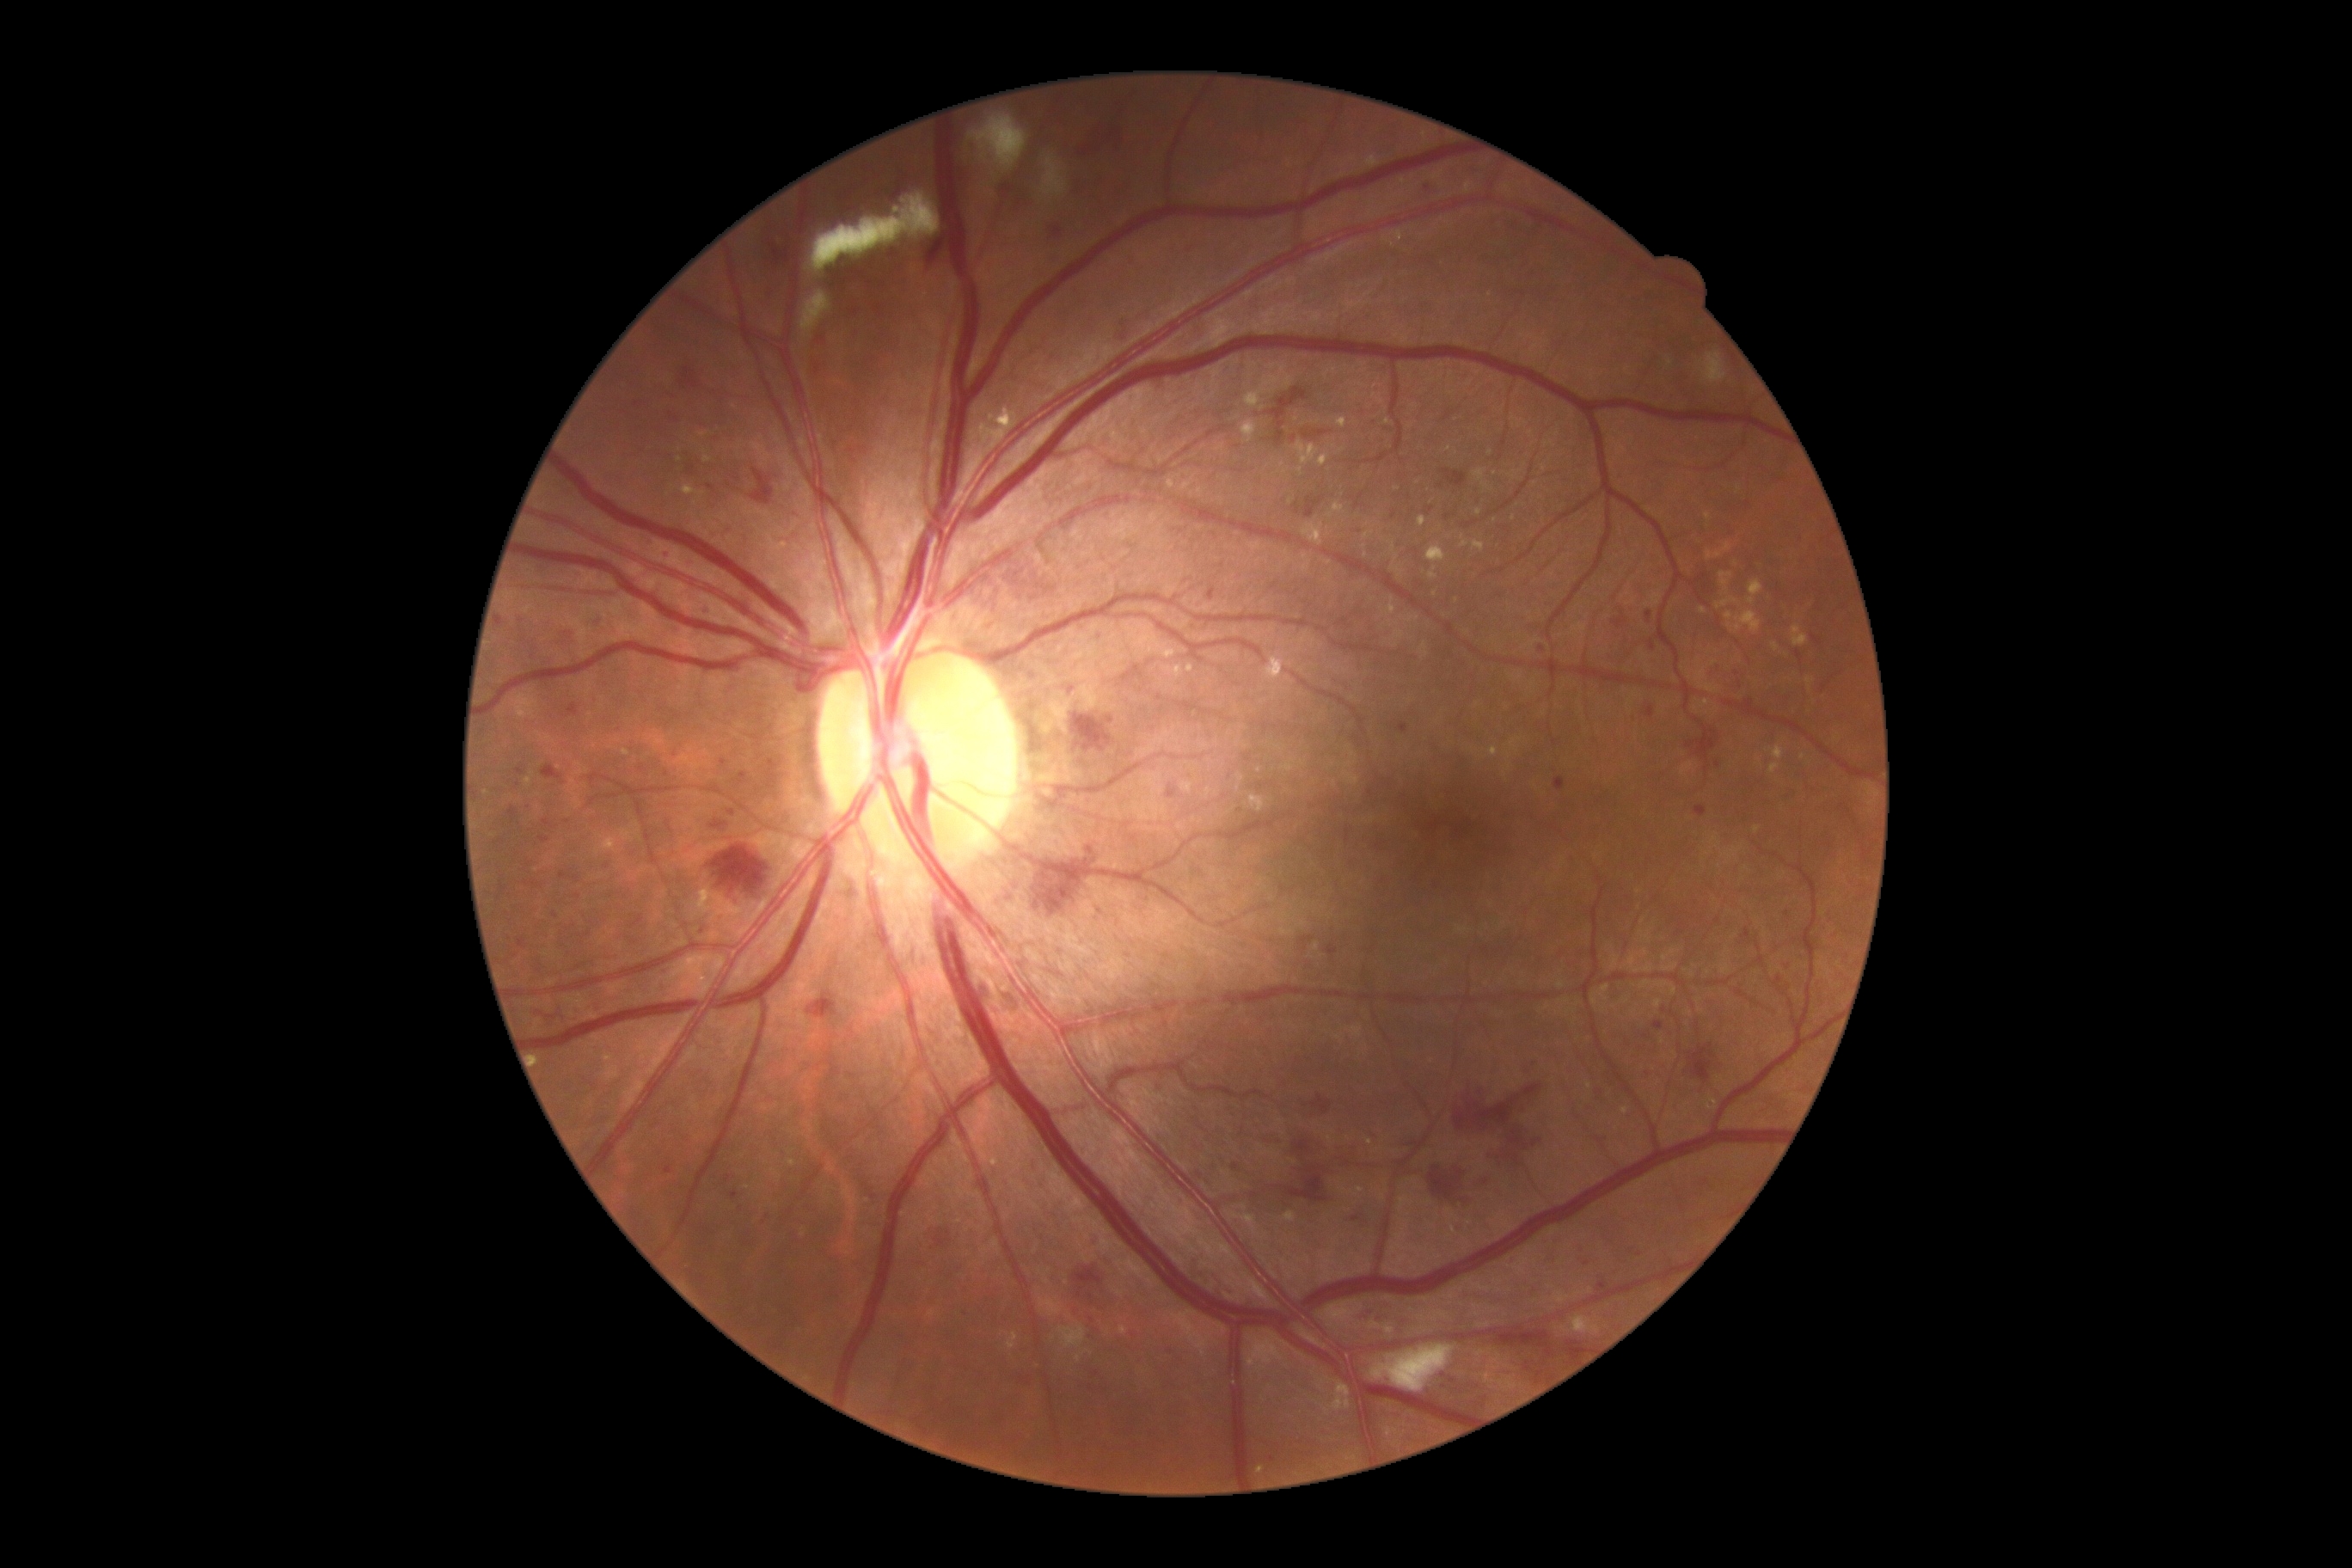 Diabetic retinopathy (DR): grade 3; non-proliferative diabetic retinopathy
A subset of detected lesions:
hard exudates (EXs) (continued): {"left": 1748, "top": 580, "right": 1763, "bottom": 606} | {"left": 1488, "top": 747, "right": 1498, "bottom": 757} | {"left": 1244, "top": 389, "right": 1261, "bottom": 408} | {"left": 1643, "top": 933, "right": 1651, "bottom": 943} | {"left": 1251, "top": 795, "right": 1266, "bottom": 812} | {"left": 1265, "top": 654, "right": 1285, "bottom": 683} | {"left": 1258, "top": 1467, "right": 1266, "bottom": 1474} | {"left": 534, "top": 1057, "right": 541, "bottom": 1067} | {"left": 1806, "top": 677, "right": 1815, "bottom": 692} | {"left": 1007, "top": 1333, "right": 1019, "bottom": 1351}
Smaller EXs around 1300:472 | 1449:449 | 1434:594 | 1342:450 | 1419:484 | 1244:1208 | 1625:1111
microaneurysms (MAs) (continued): {"left": 1555, "top": 778, "right": 1565, "bottom": 792} | {"left": 1421, "top": 183, "right": 1438, "bottom": 199} | {"left": 1208, "top": 589, "right": 1216, "bottom": 601} | {"left": 713, "top": 821, "right": 726, "bottom": 830} | {"left": 630, "top": 916, "right": 644, "bottom": 929} | {"left": 539, "top": 838, "right": 549, "bottom": 845} | {"left": 518, "top": 940, "right": 527, "bottom": 948} | {"left": 689, "top": 467, "right": 695, "bottom": 475} | {"left": 1598, "top": 1282, "right": 1607, "bottom": 1292} | {"left": 1087, "top": 847, "right": 1094, "bottom": 855}
Smaller MAs around 1292:439 | 723:763 | 576:879 | 1748:504 | 671:415 | 1541:649 | 1447:517 | 676:756 | 1369:1166